45° FOV · 1932x1910px.
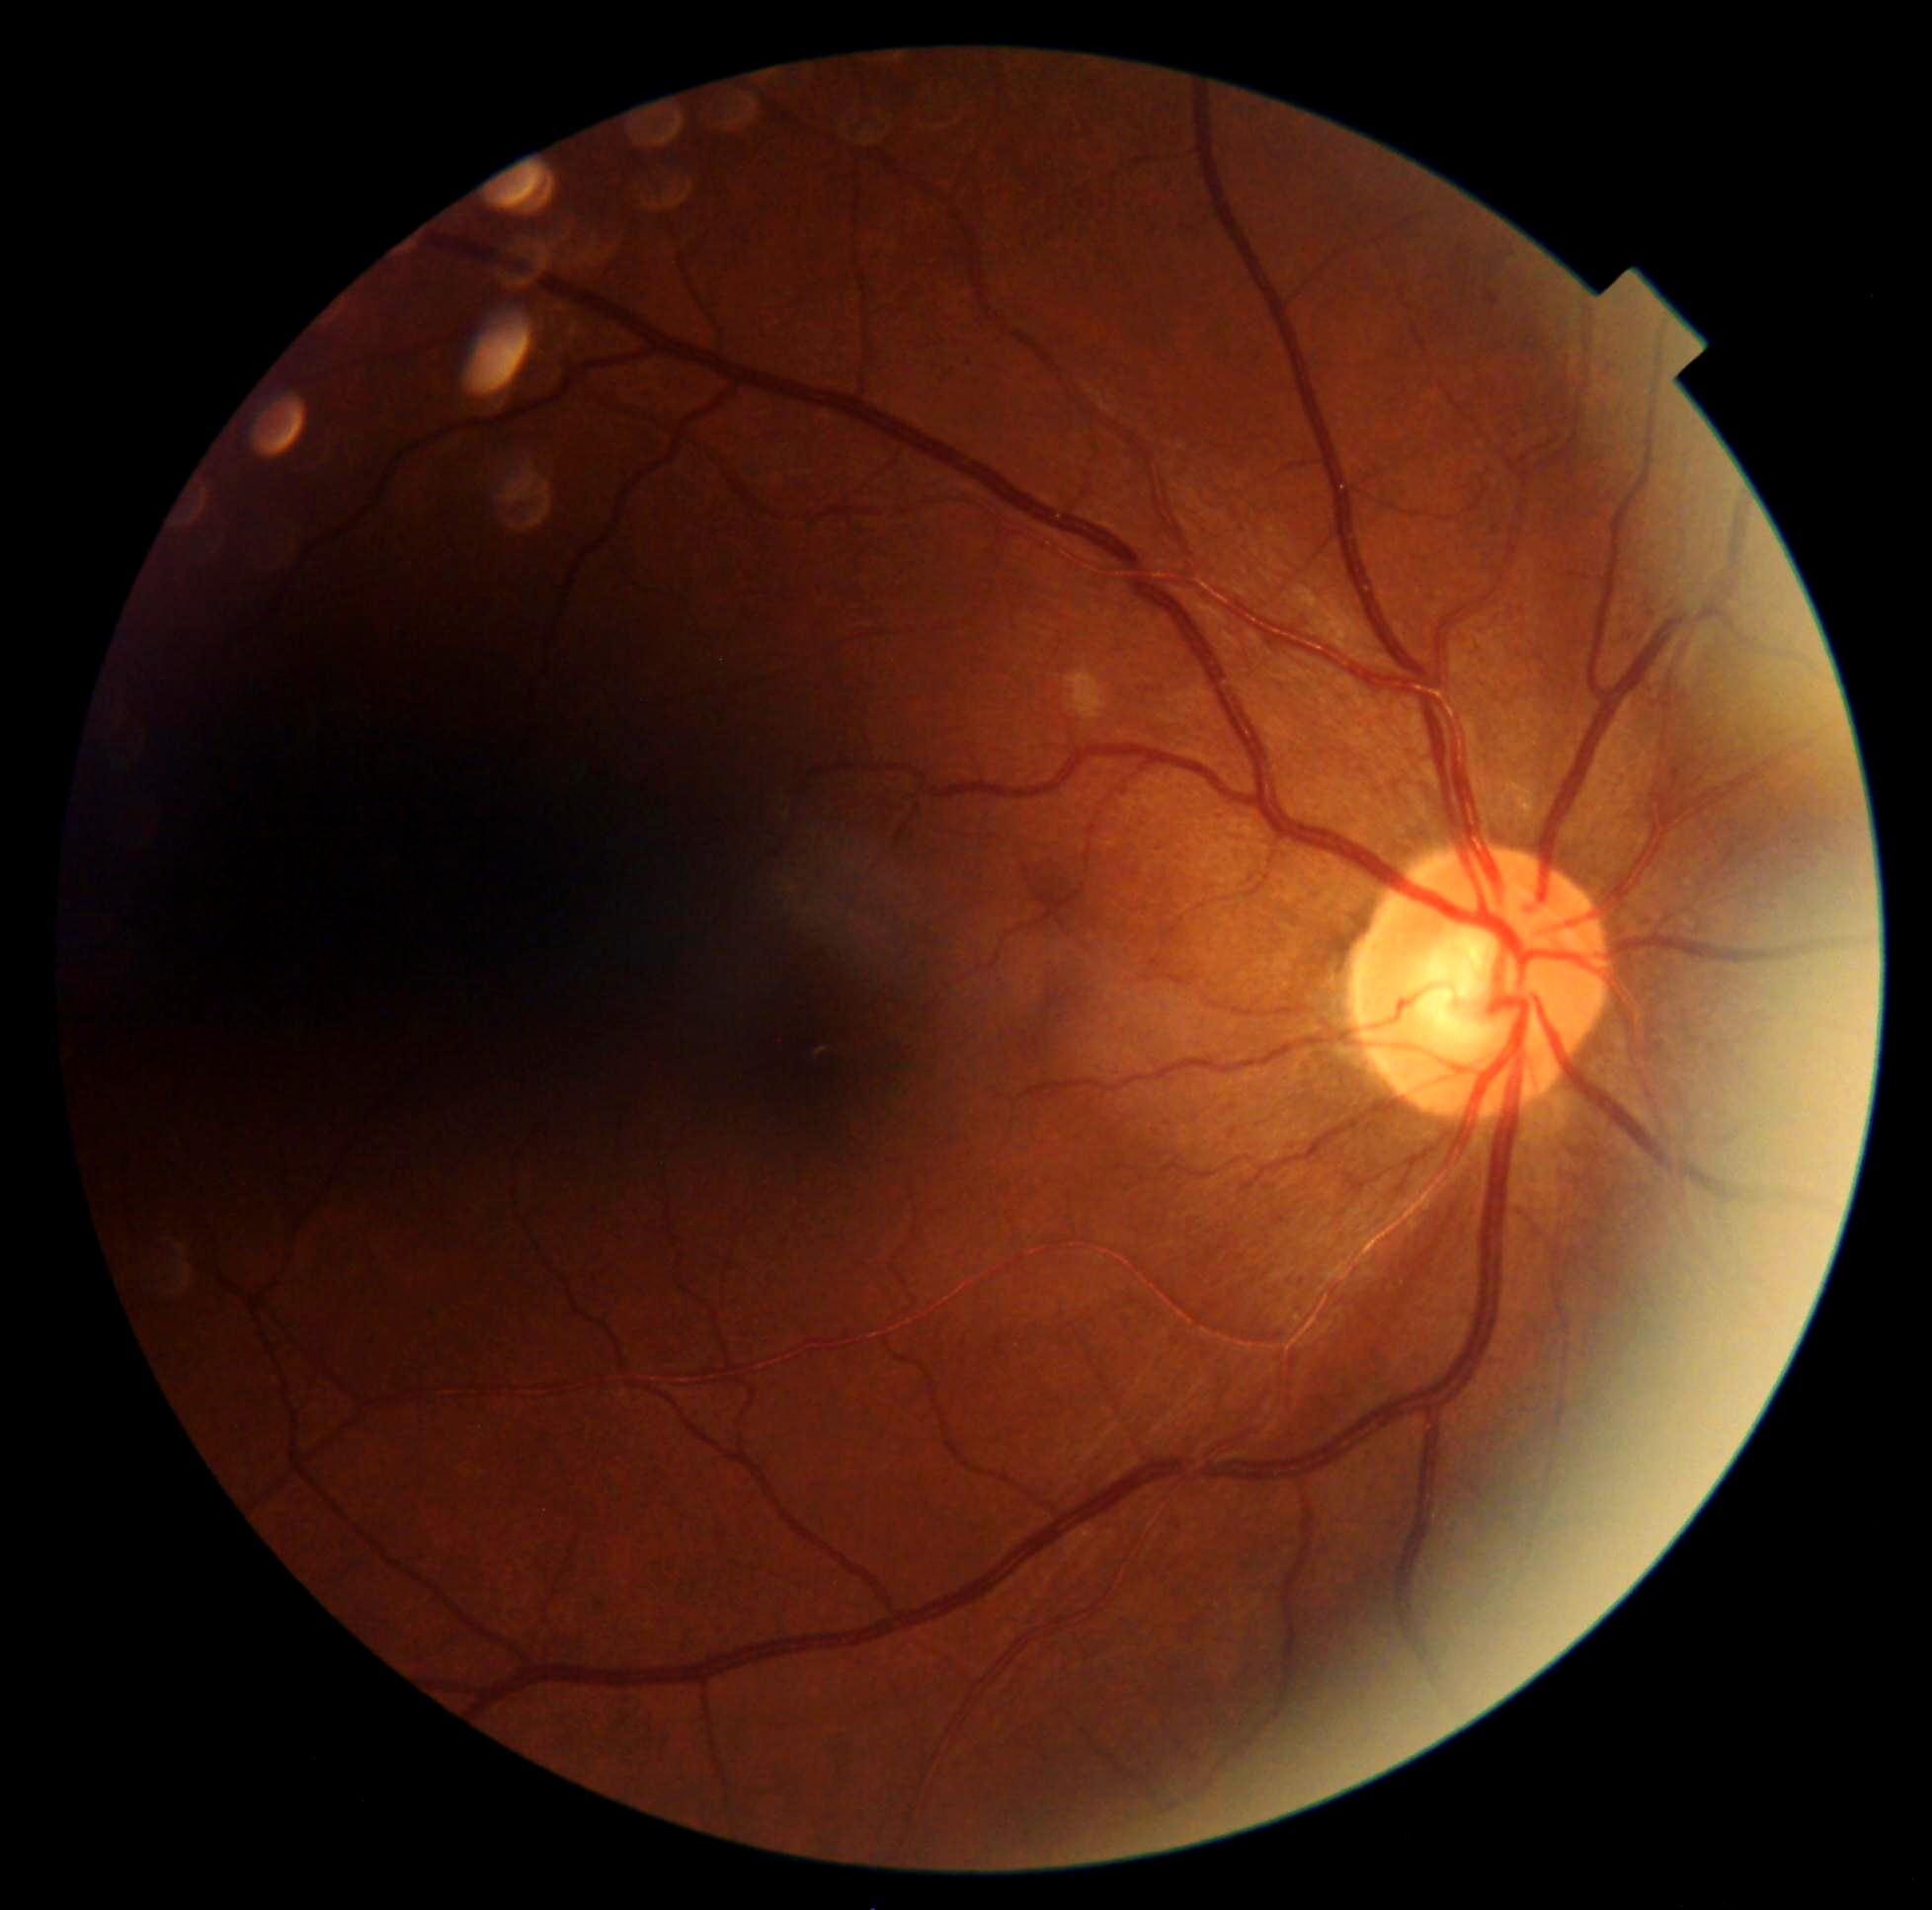 Diabetic retinopathy (DR) is grade 1 (mild NPDR) — presence of microaneurysms only.